Nonmydriatic fundus photograph; 848x848; posterior pole color fundus photograph:
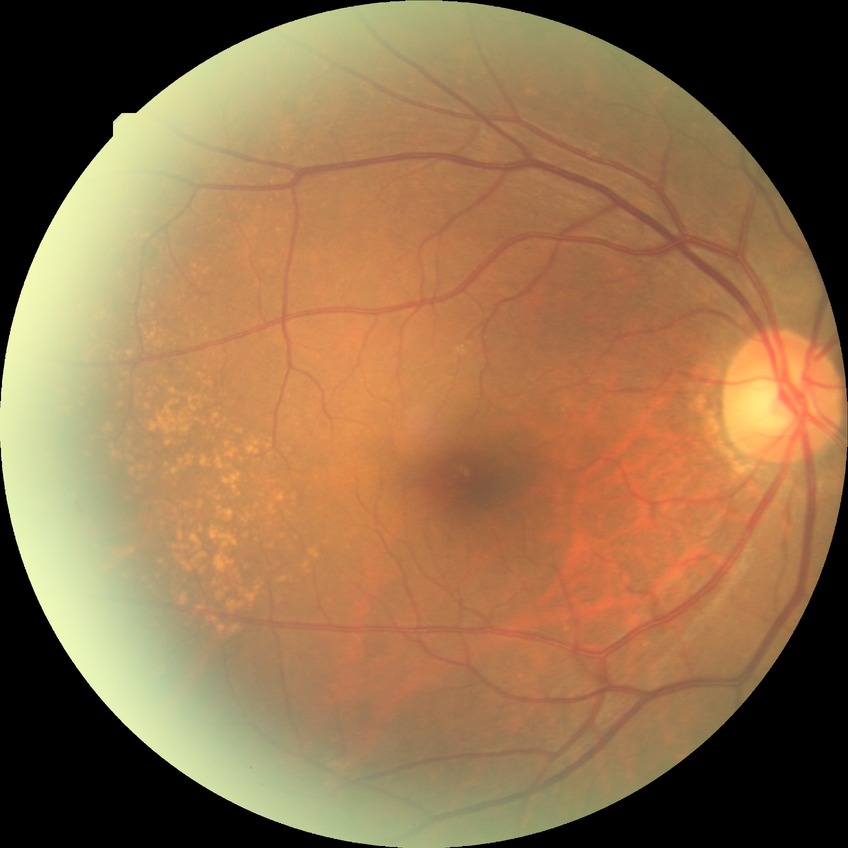

Diabetic retinopathy (DR) is NDR (no diabetic retinopathy).